848x848. Color fundus image. NIDEK AFC-230. No pharmacologic dilation. 45° FOV:
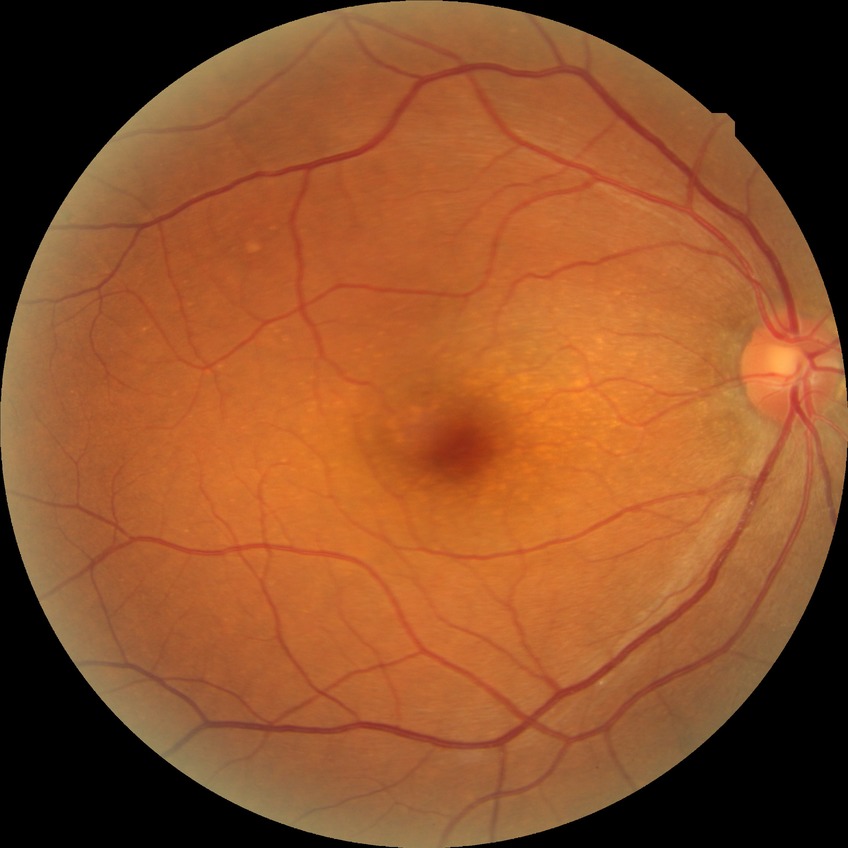
Diabetic retinopathy (DR): NDR (no diabetic retinopathy).